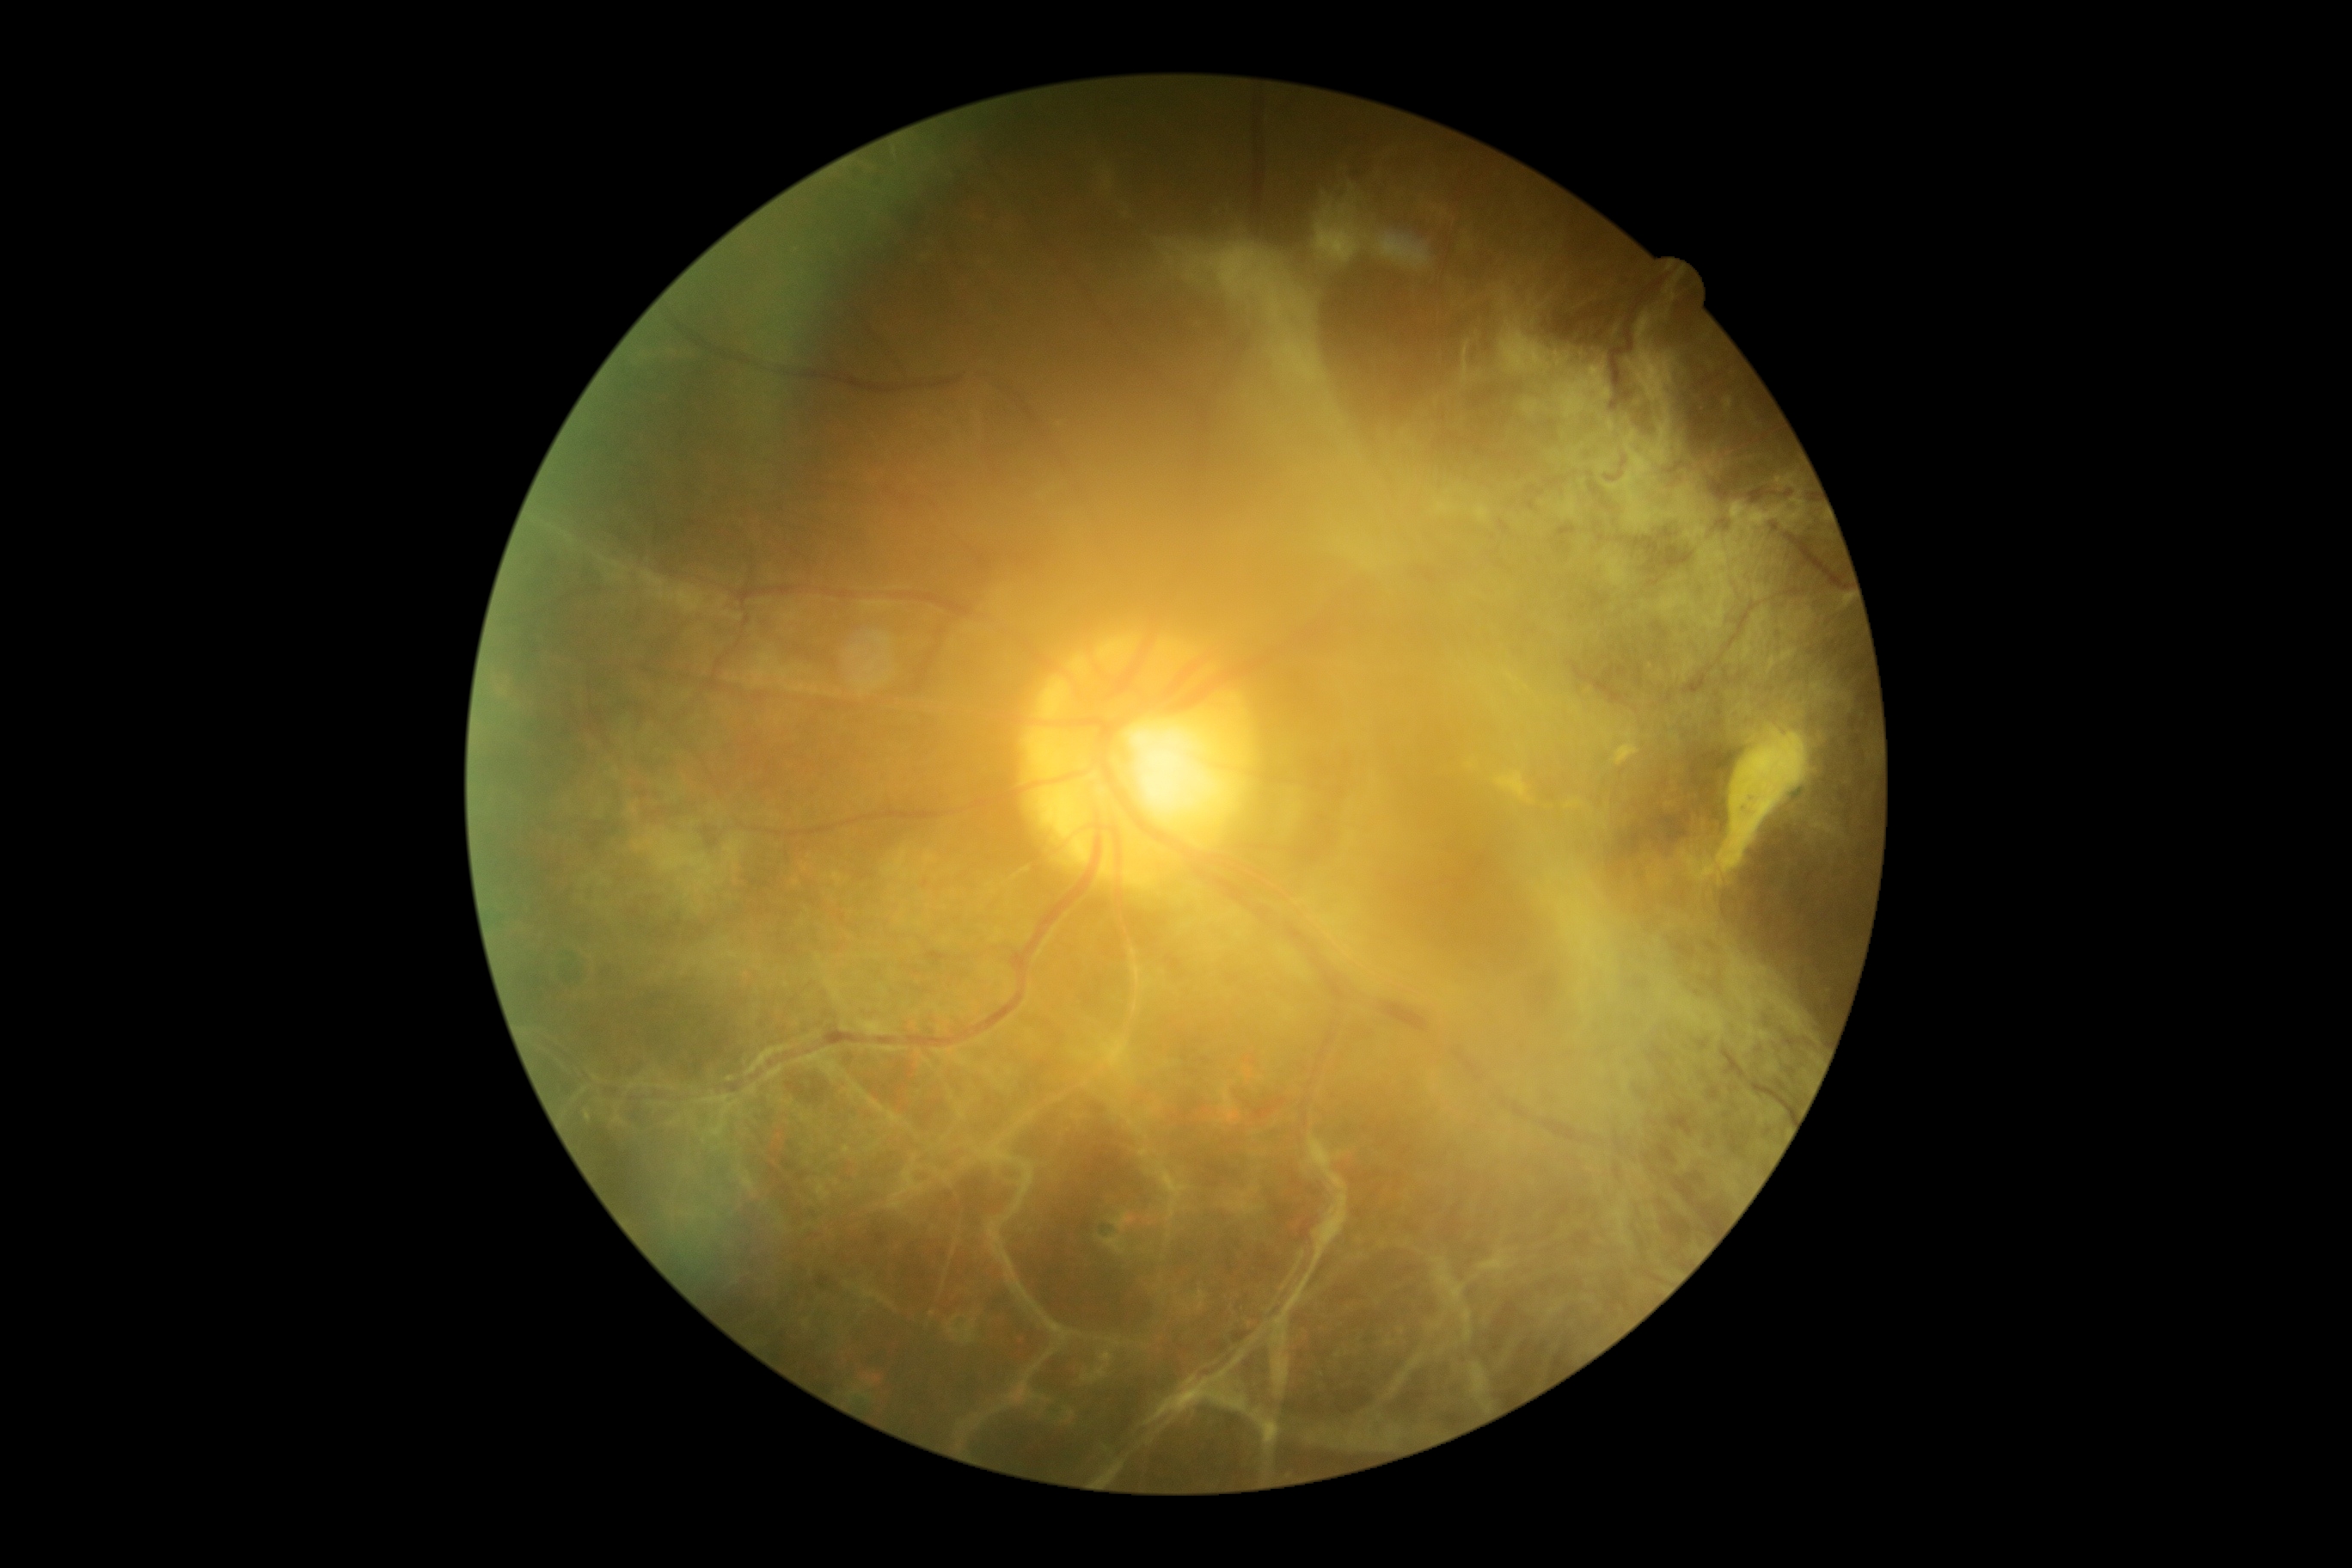

{"dr_grade": "proliferative diabetic retinopathy (grade 4)", "dr_category": "proliferative diabetic retinopathy"}